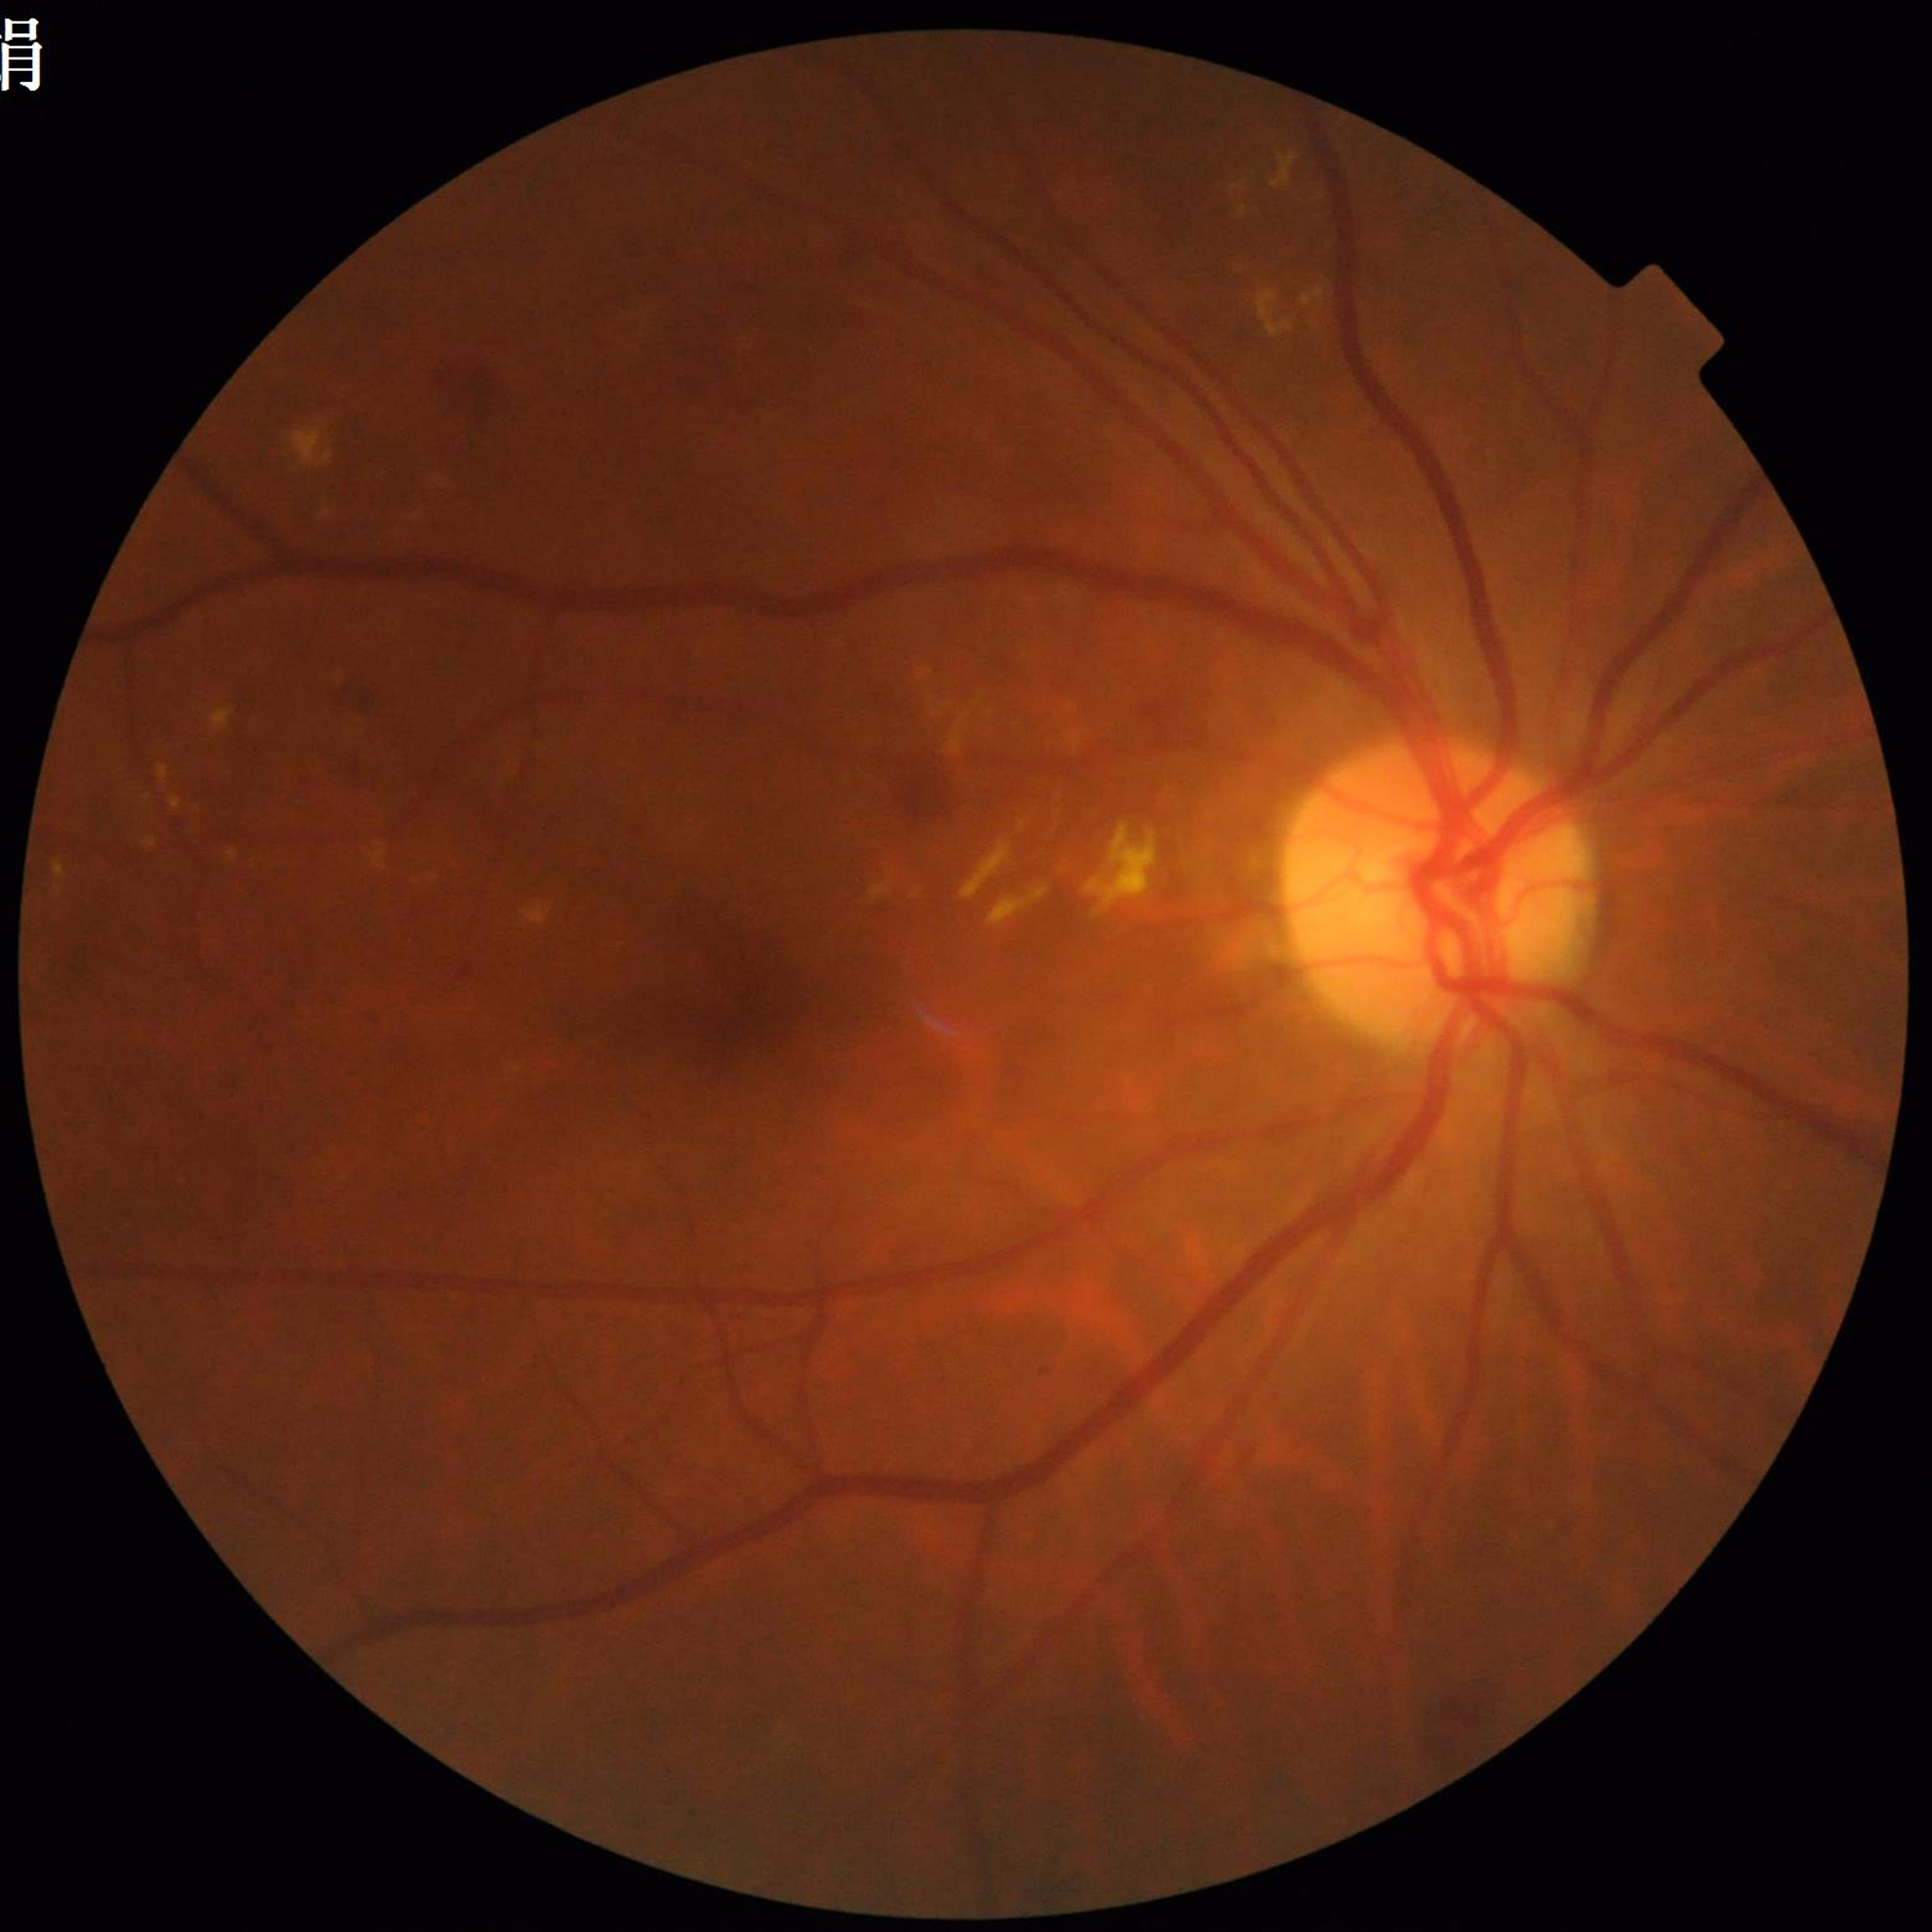
Diagnosis: diabetic retinopathy.